Image size 2352x1568.
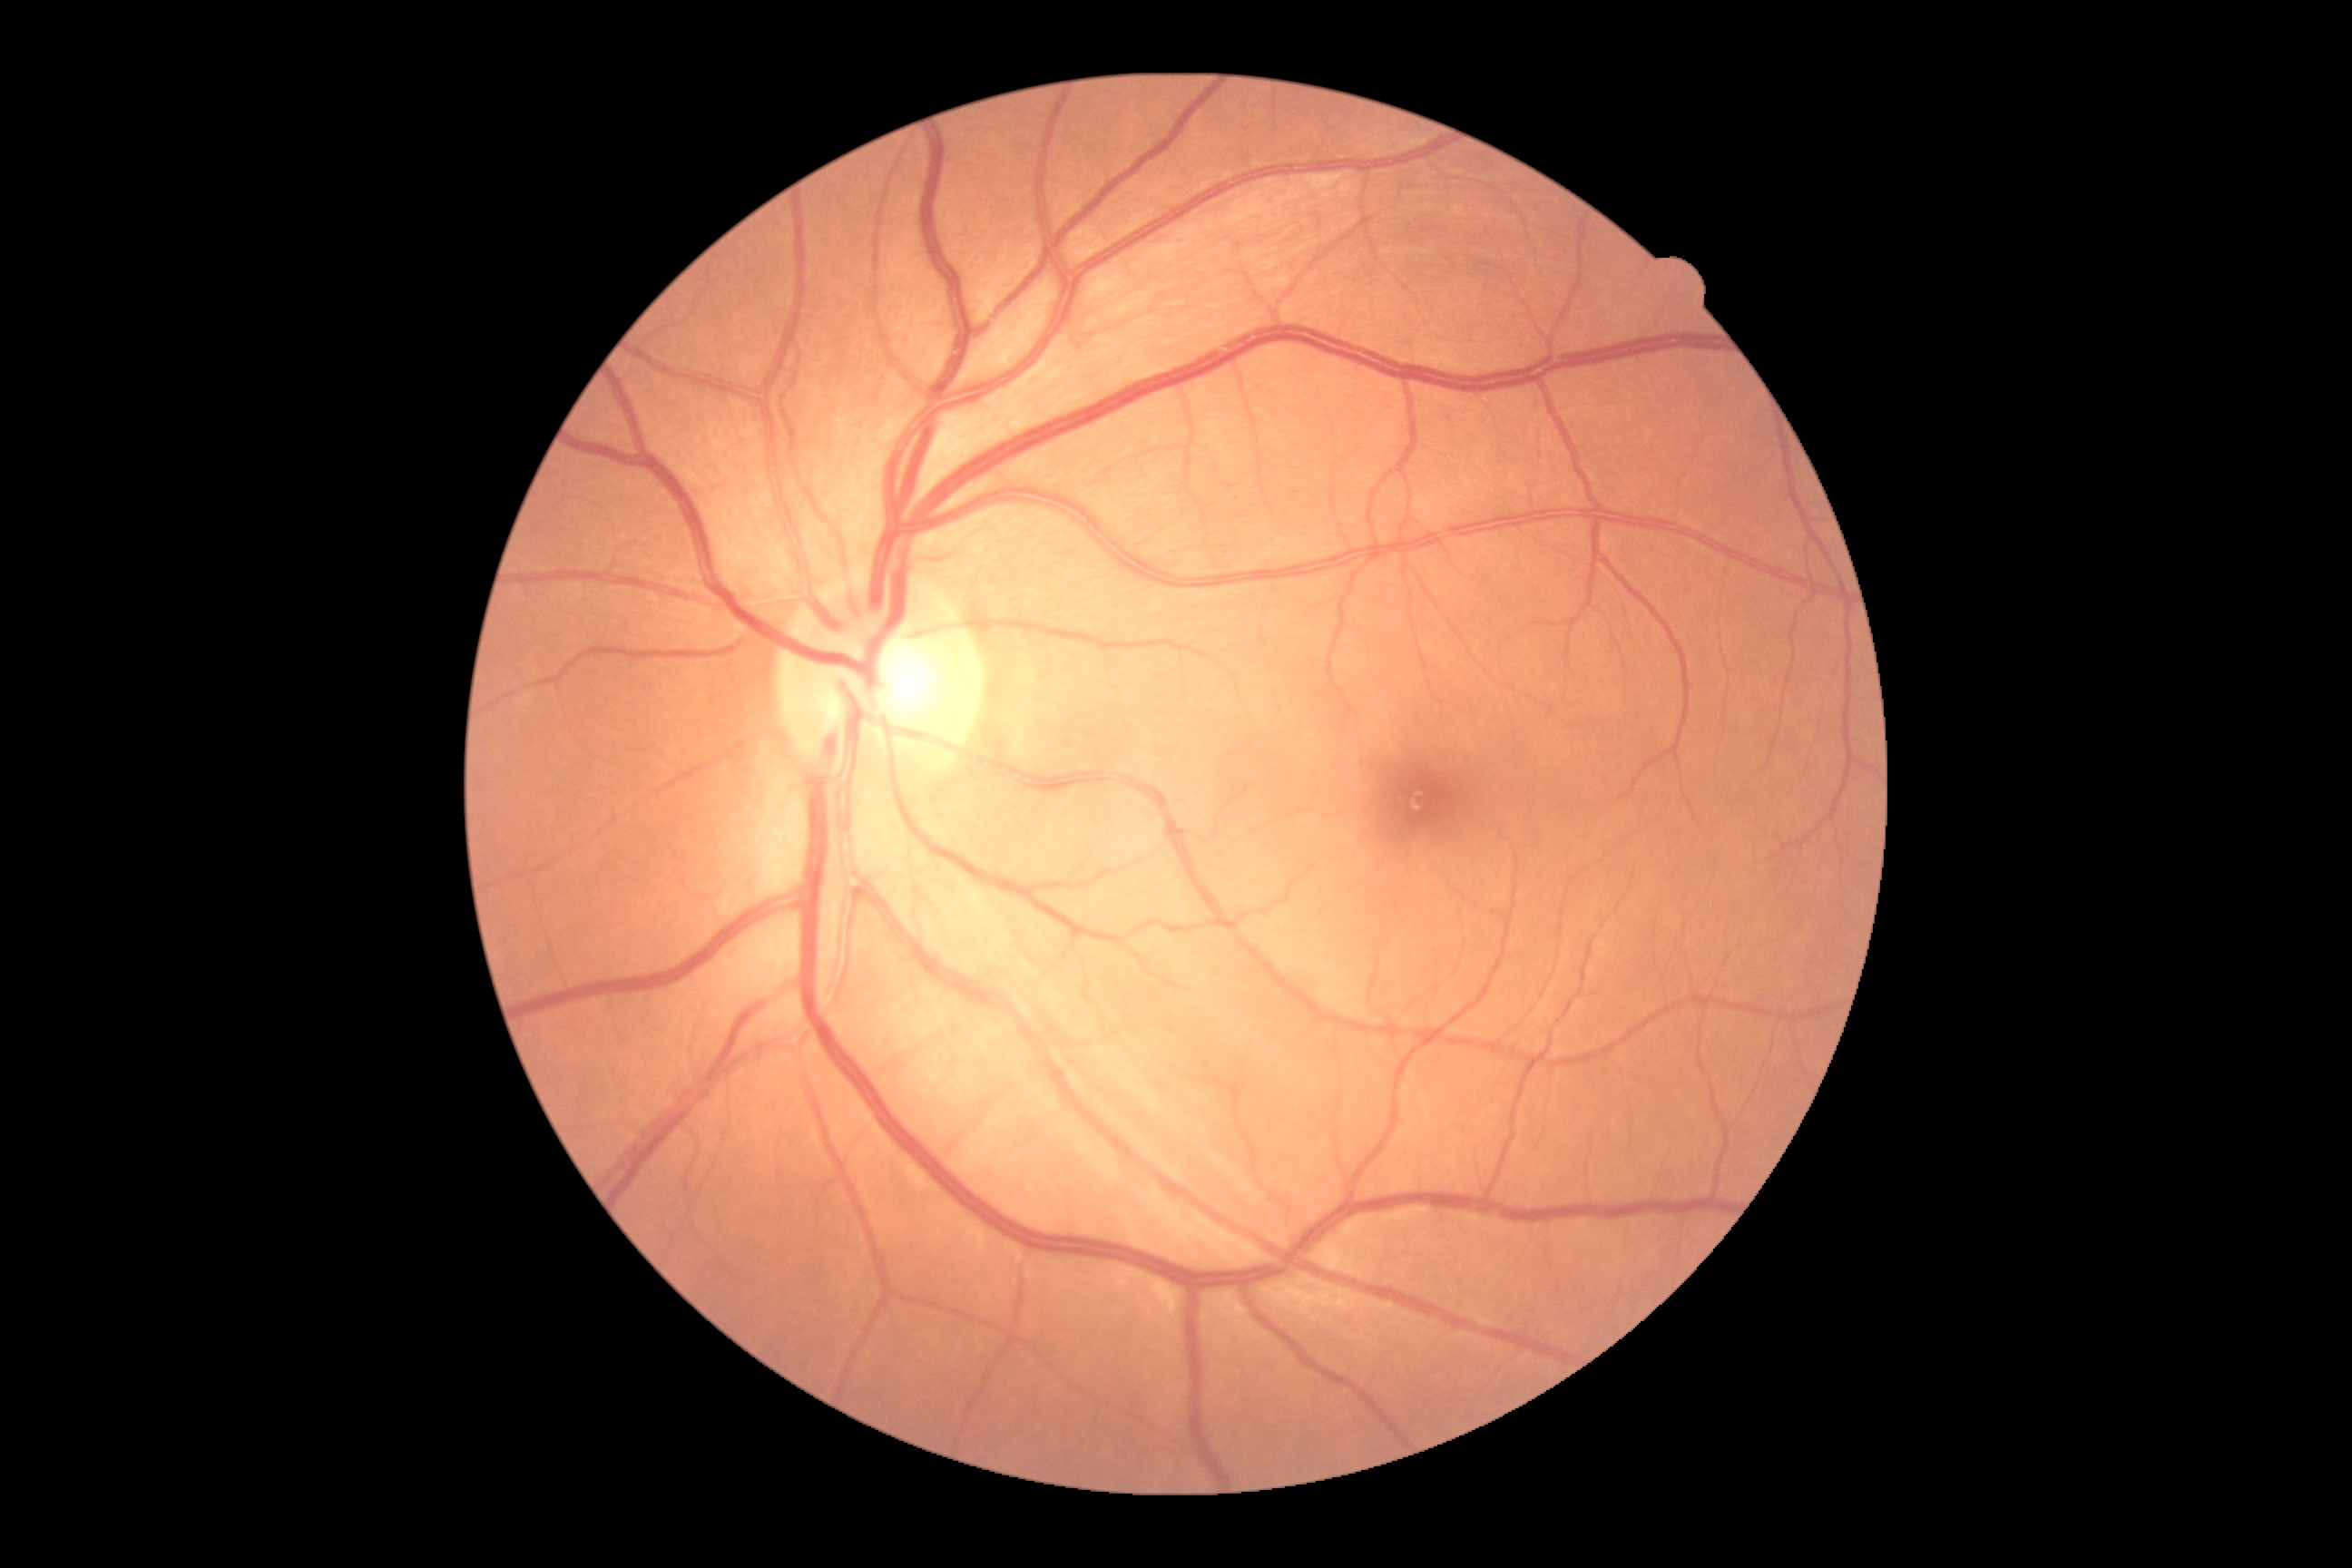 DR stage=no apparent retinopathy (grade 0) — no visible signs of diabetic retinopathy, DR impression=no DR findings.